2048 x 1536 pixels — 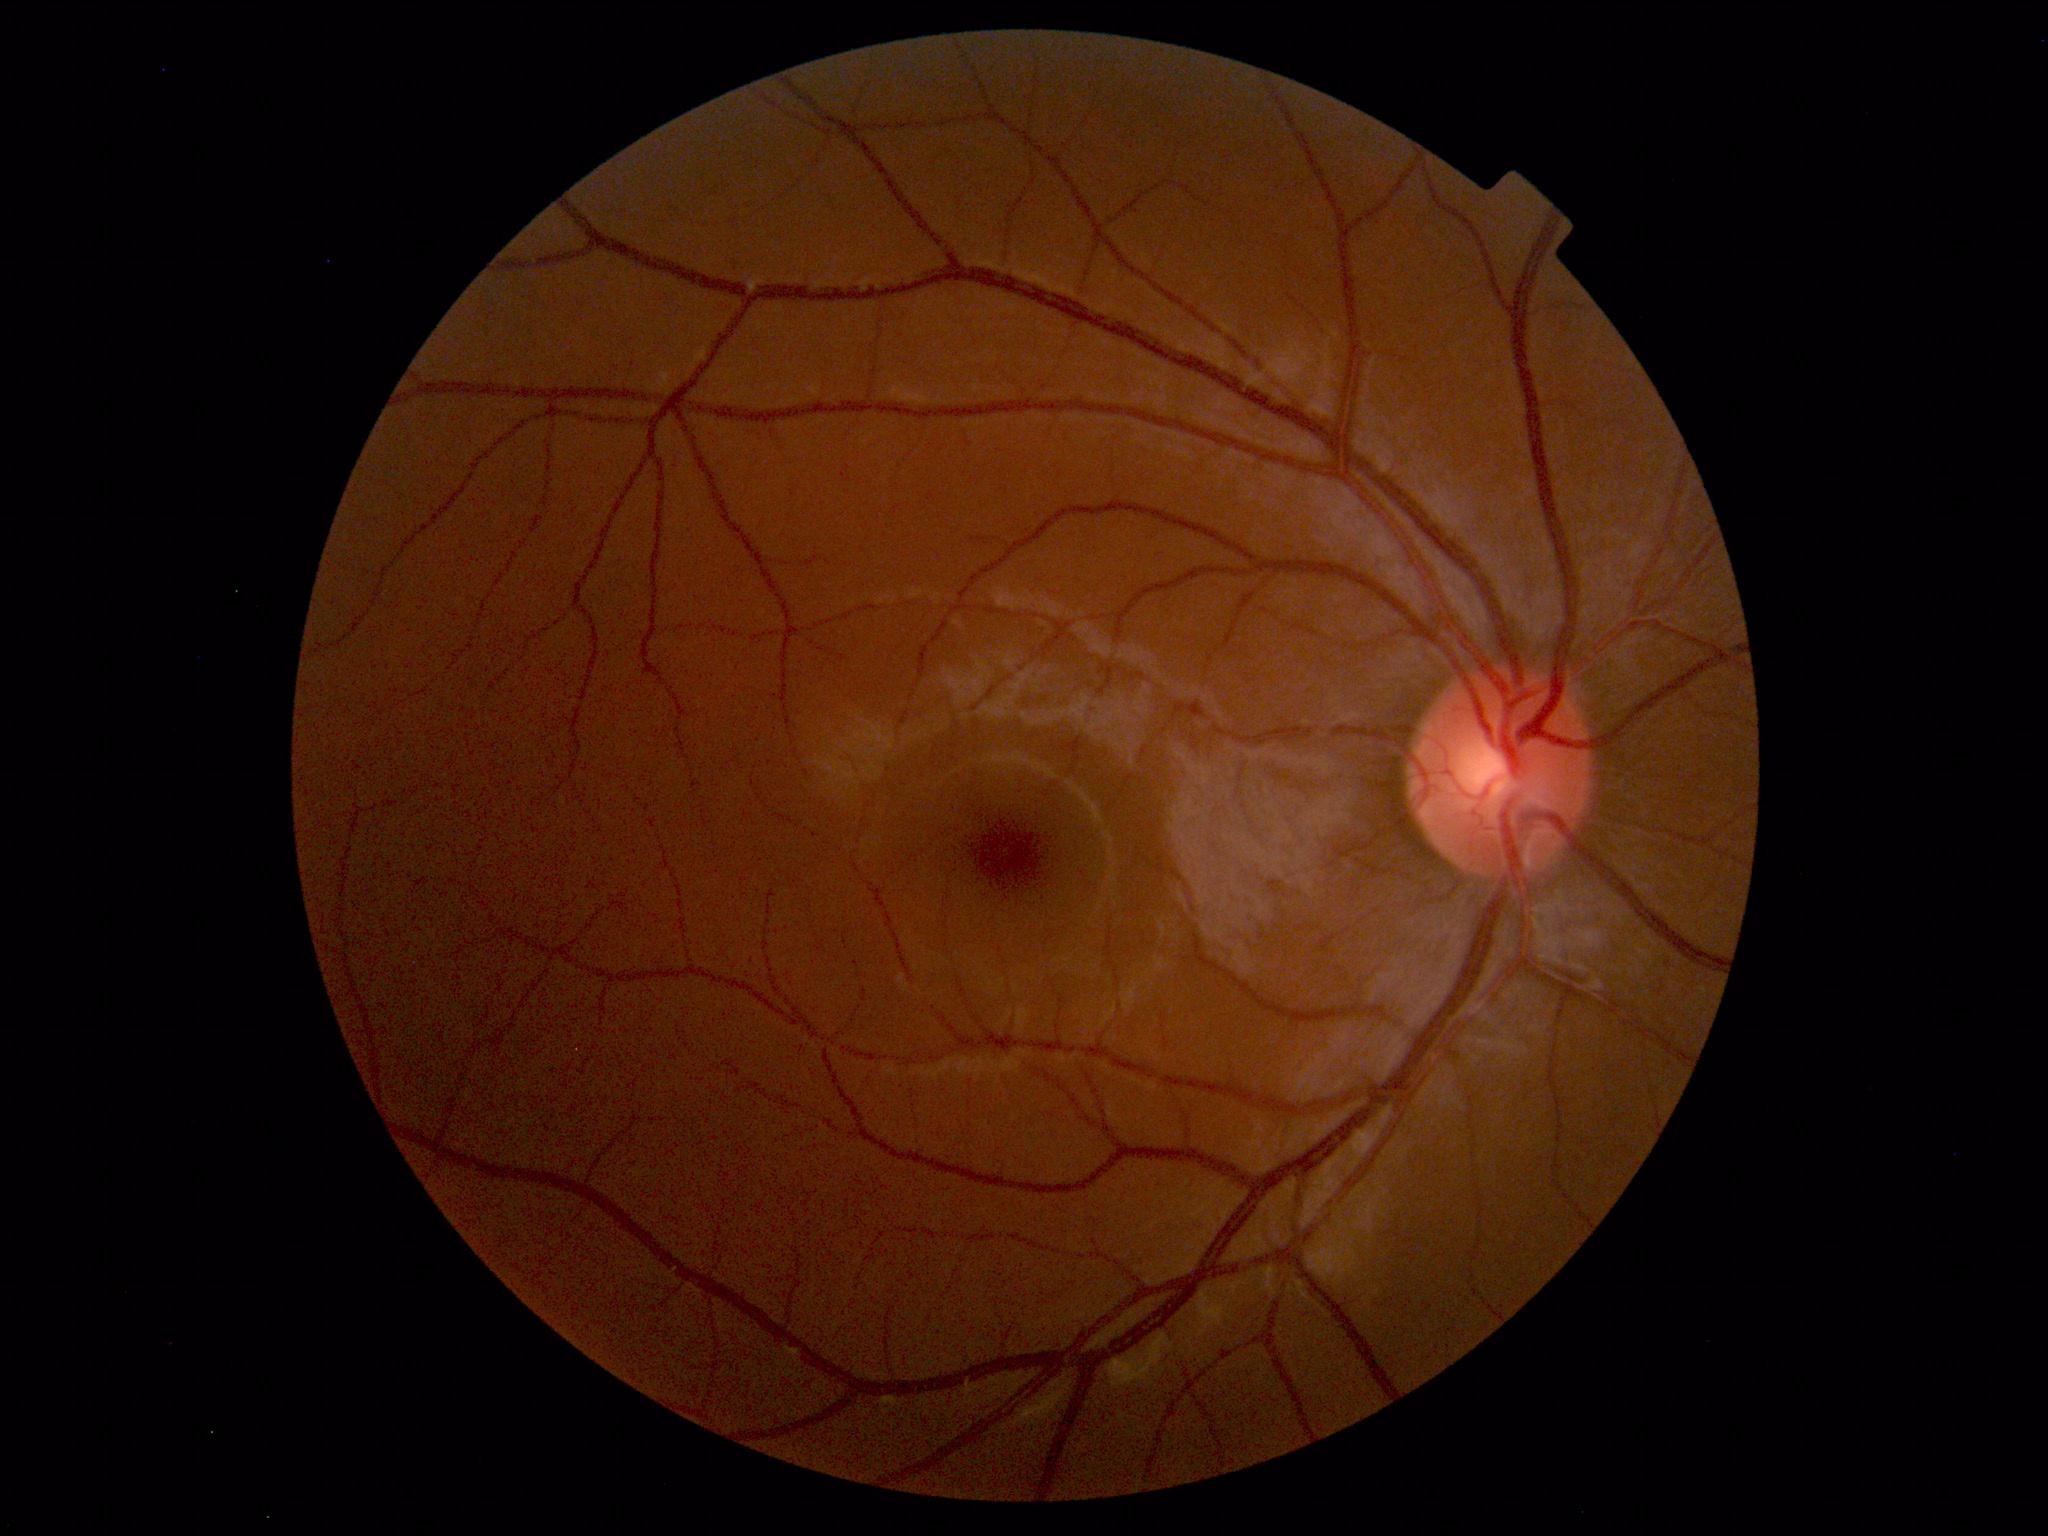
Normal color fundus photograph.